Camera: Forus 3Nethra Classic; fundus photo — 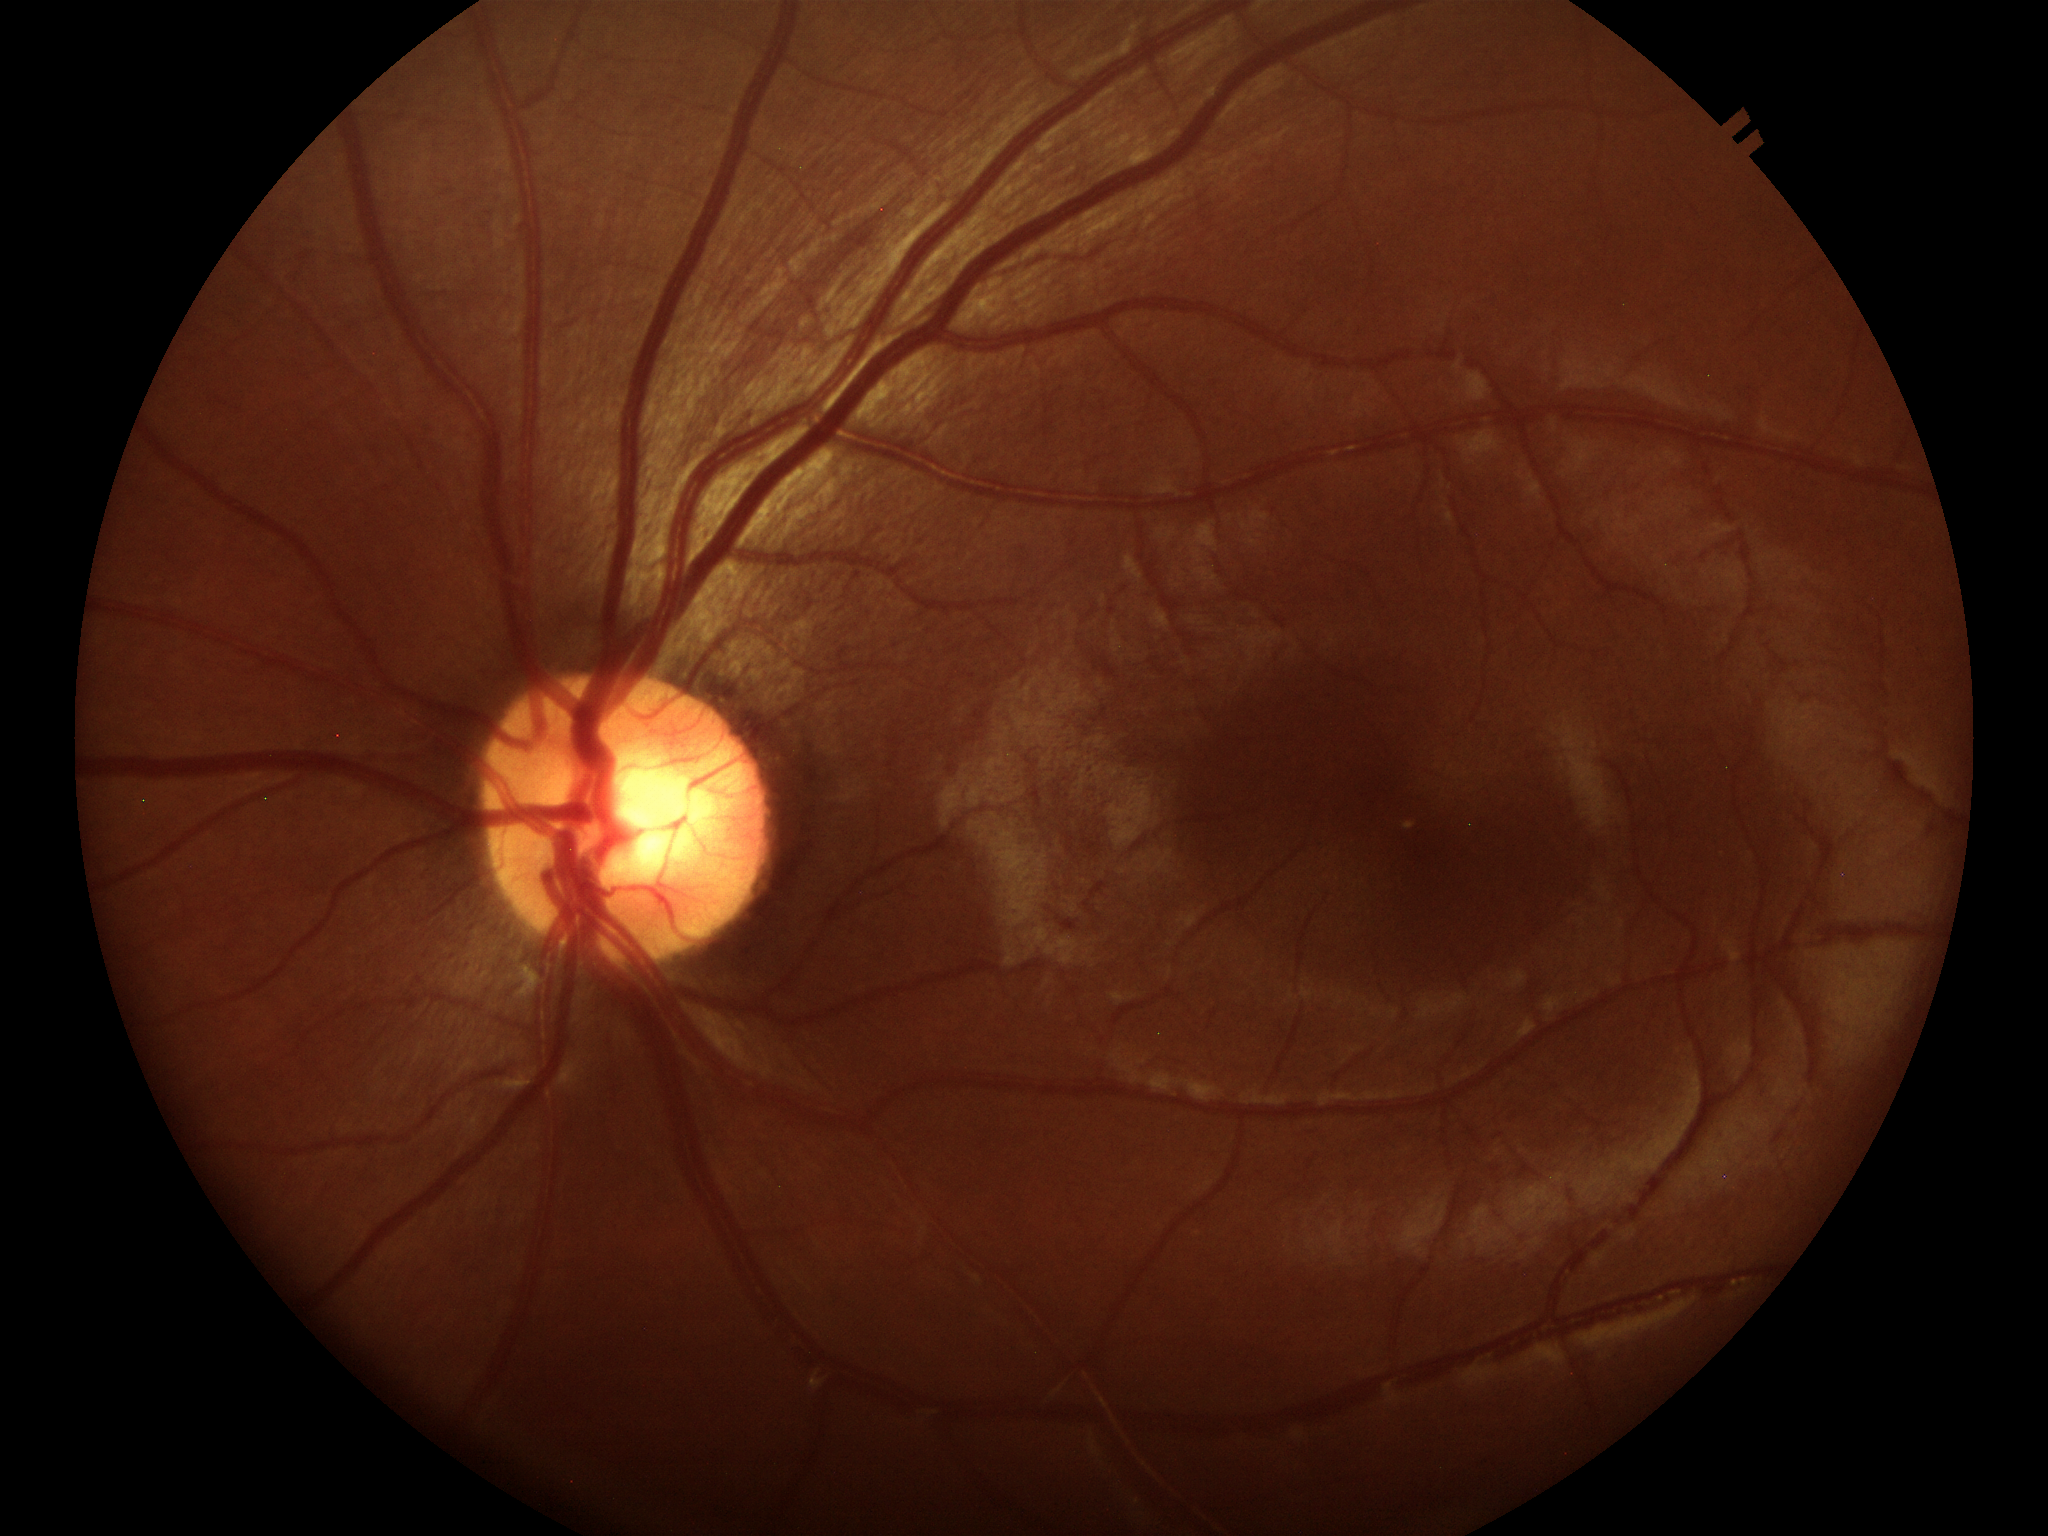 No glaucomatous findings. Vertical CDR is 0.53.